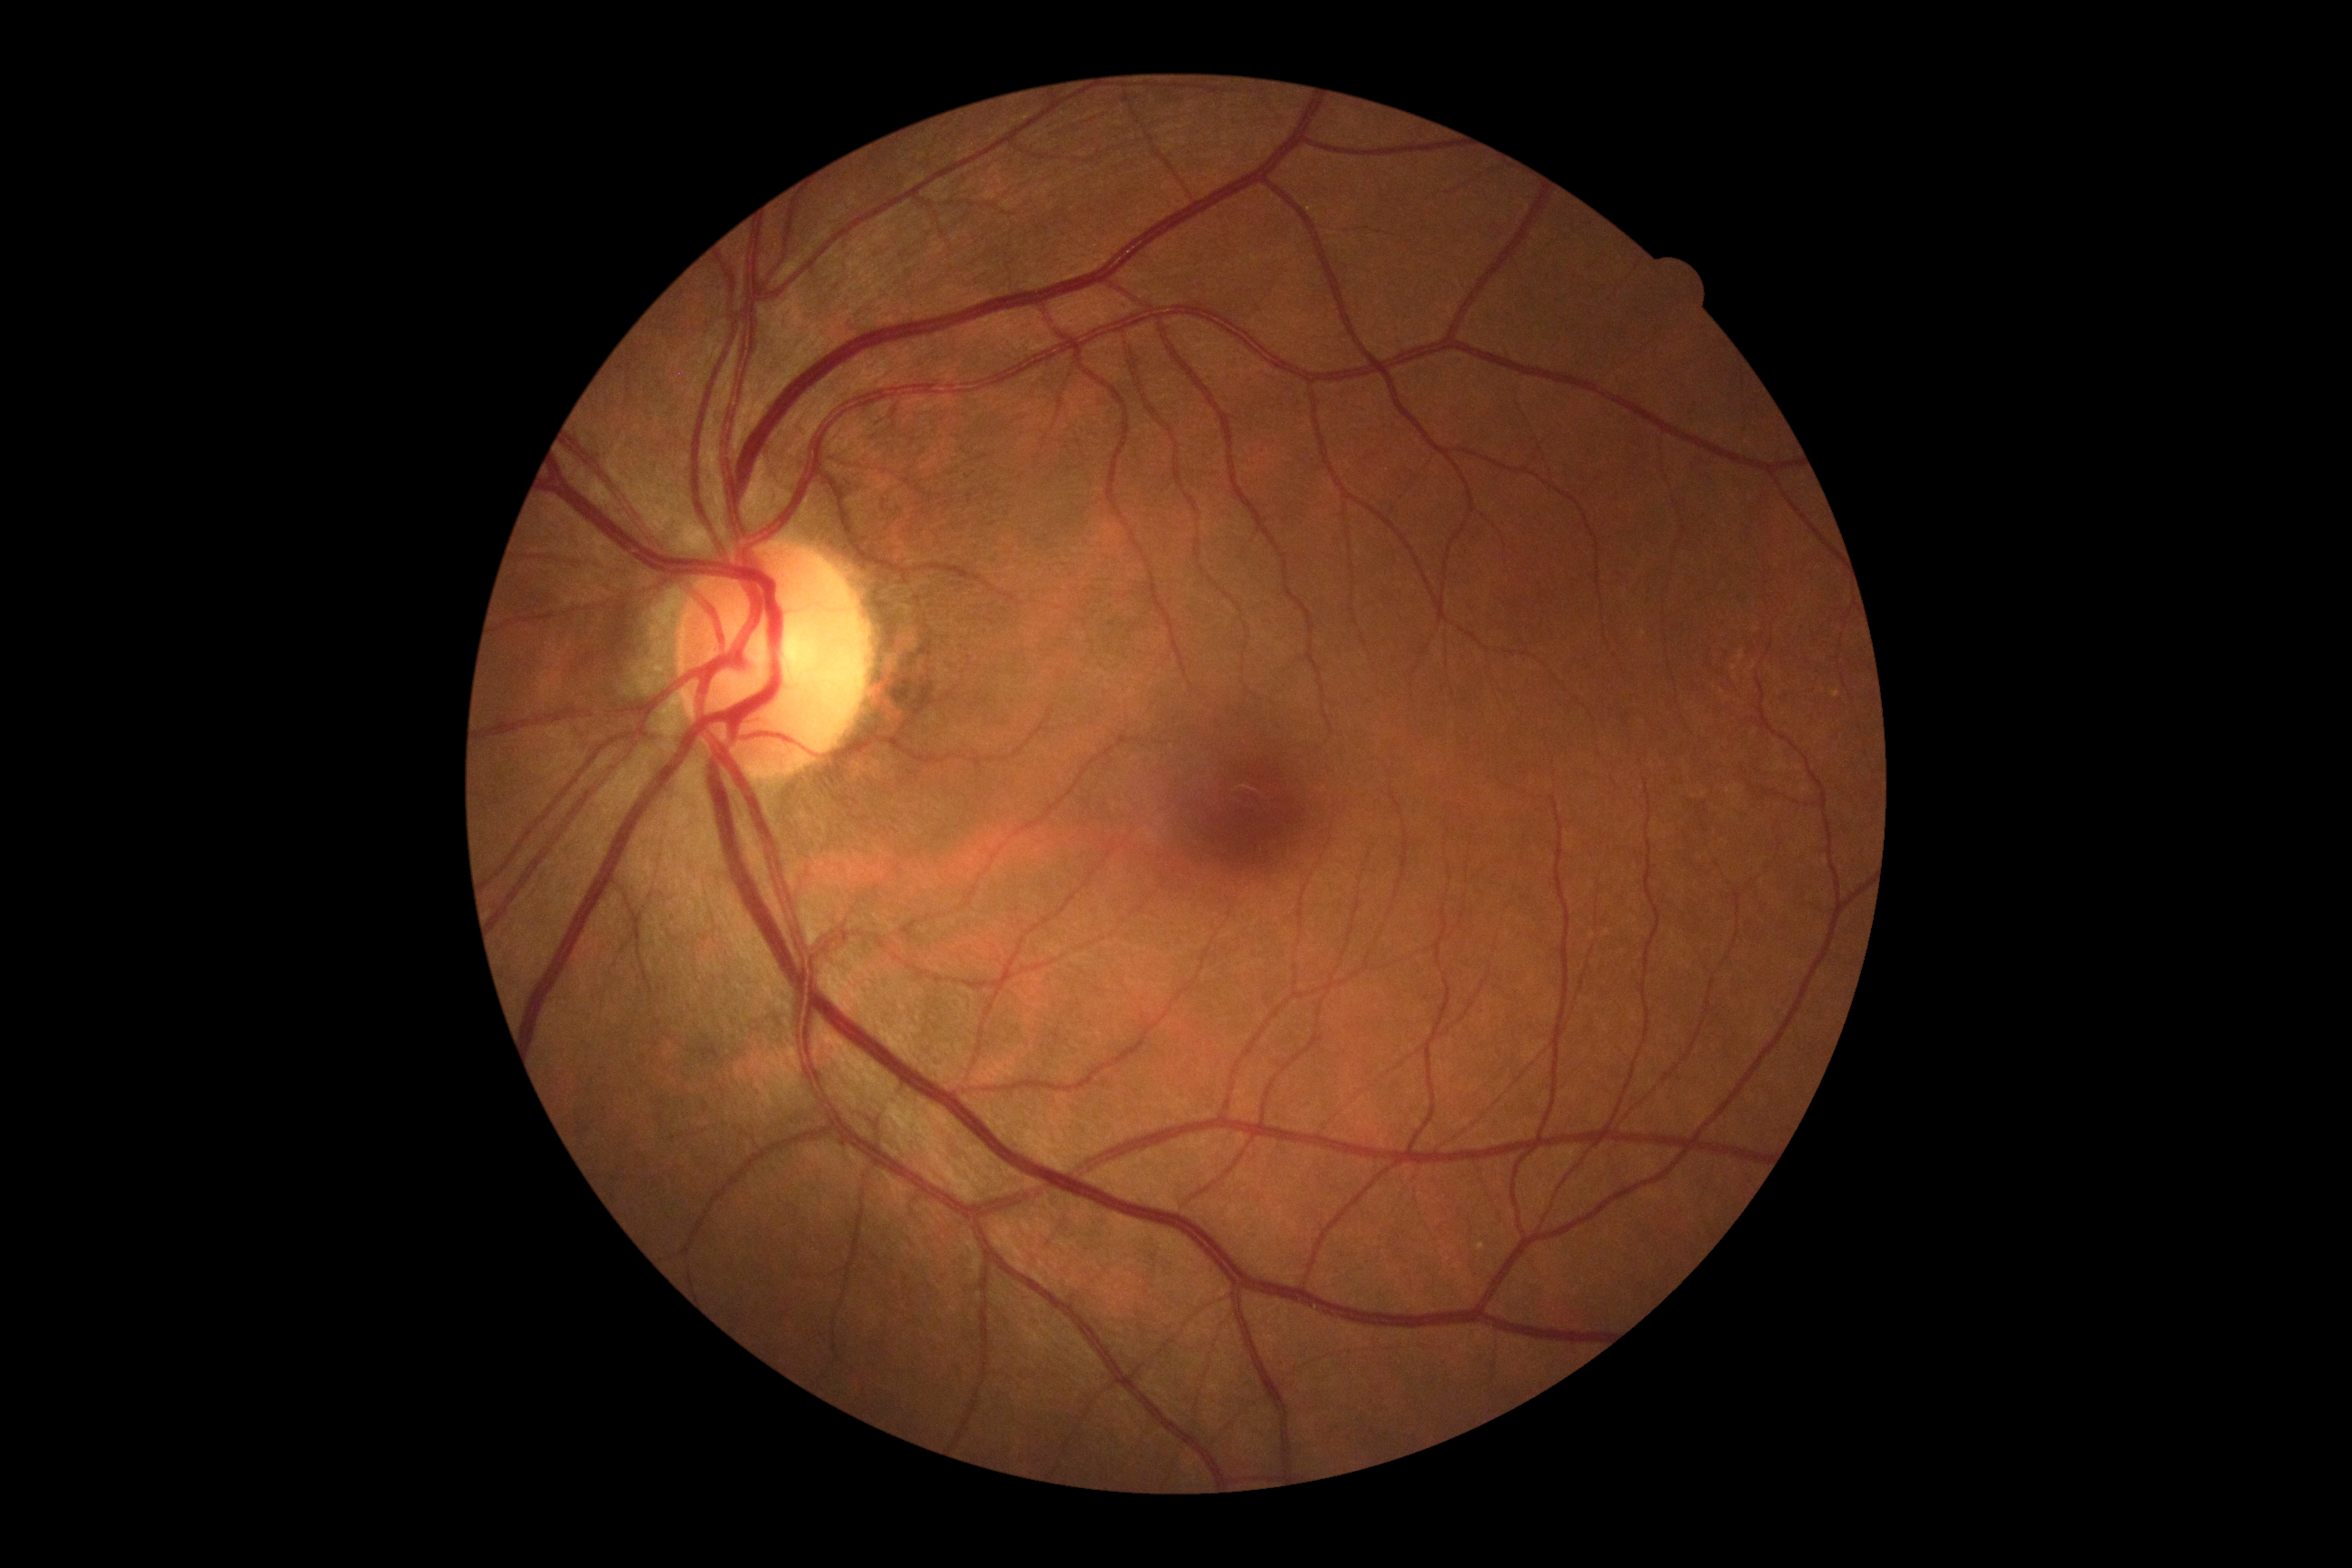

DR stage@0/4 — no visible signs of diabetic retinopathy.